IOP 21 mmHg. Gender: M. Age 73. 30-degree field of view. Pachymetry 559 µm. Axial length (AL) 23.15 mm. Autorefraction: +1 -1.75 × 82° — 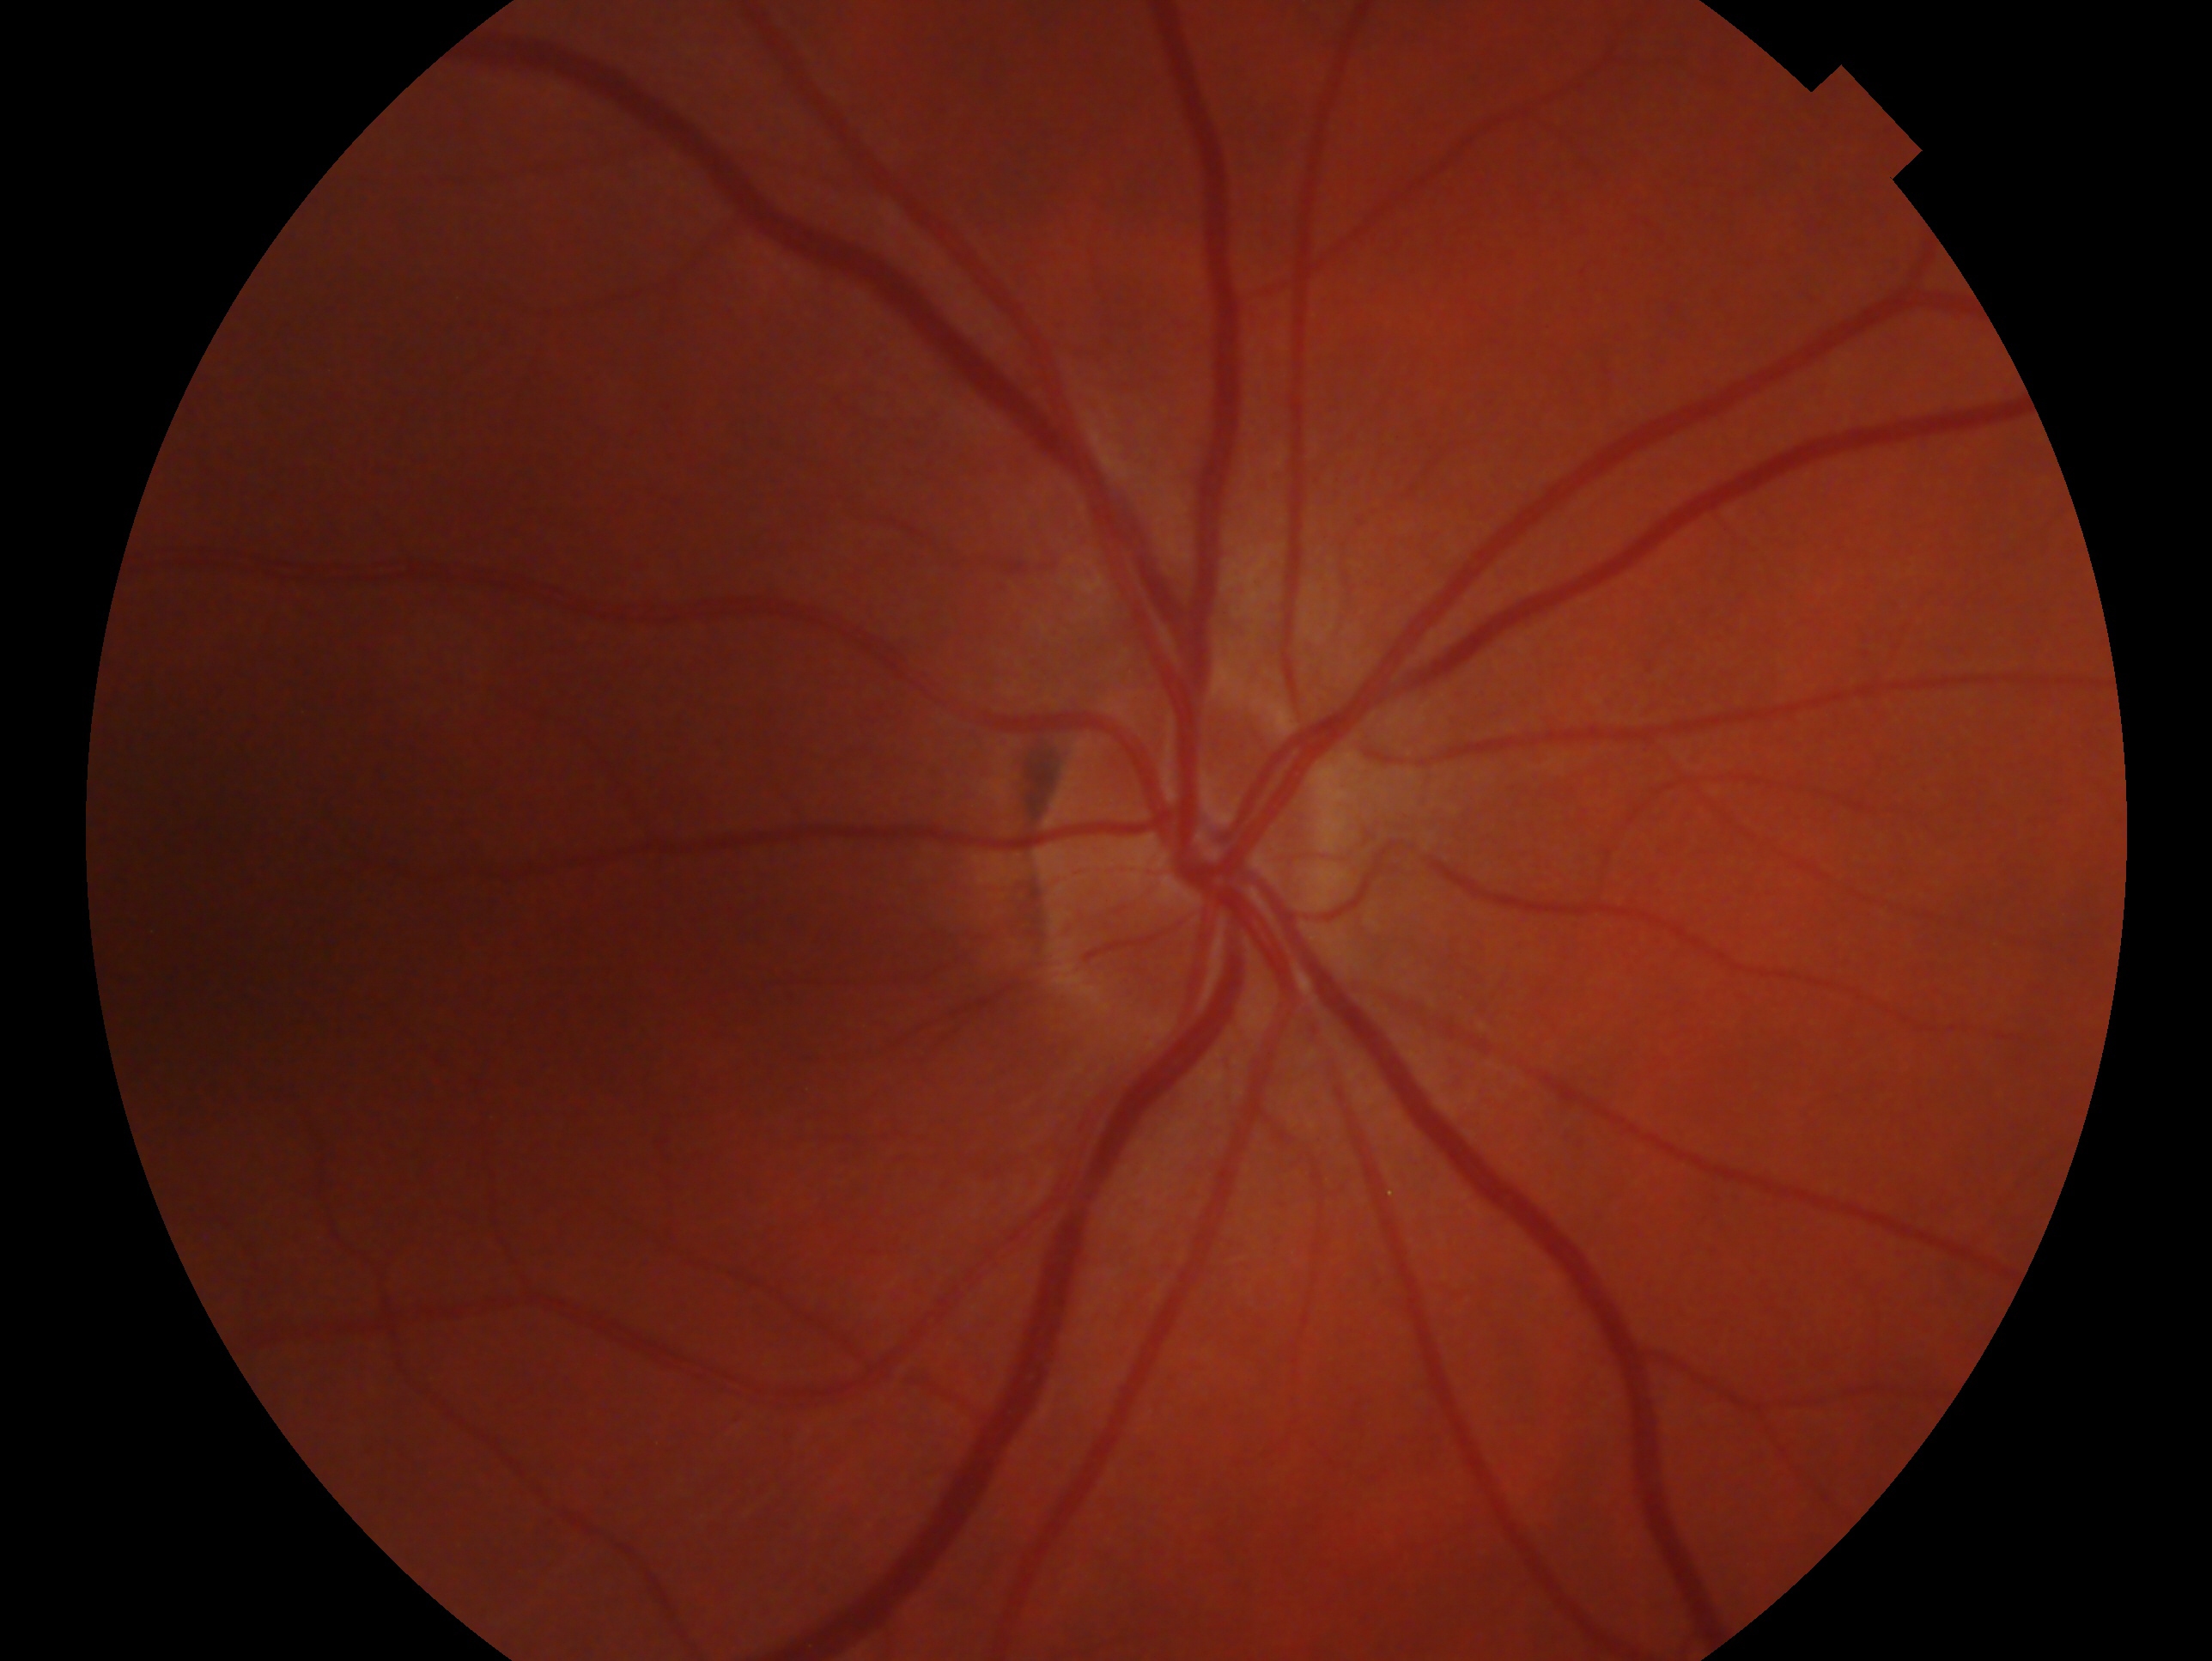 laterality = oculus dexter | glaucoma assessment = negative for glaucoma — no clinical evidence of glaucoma in this eye.